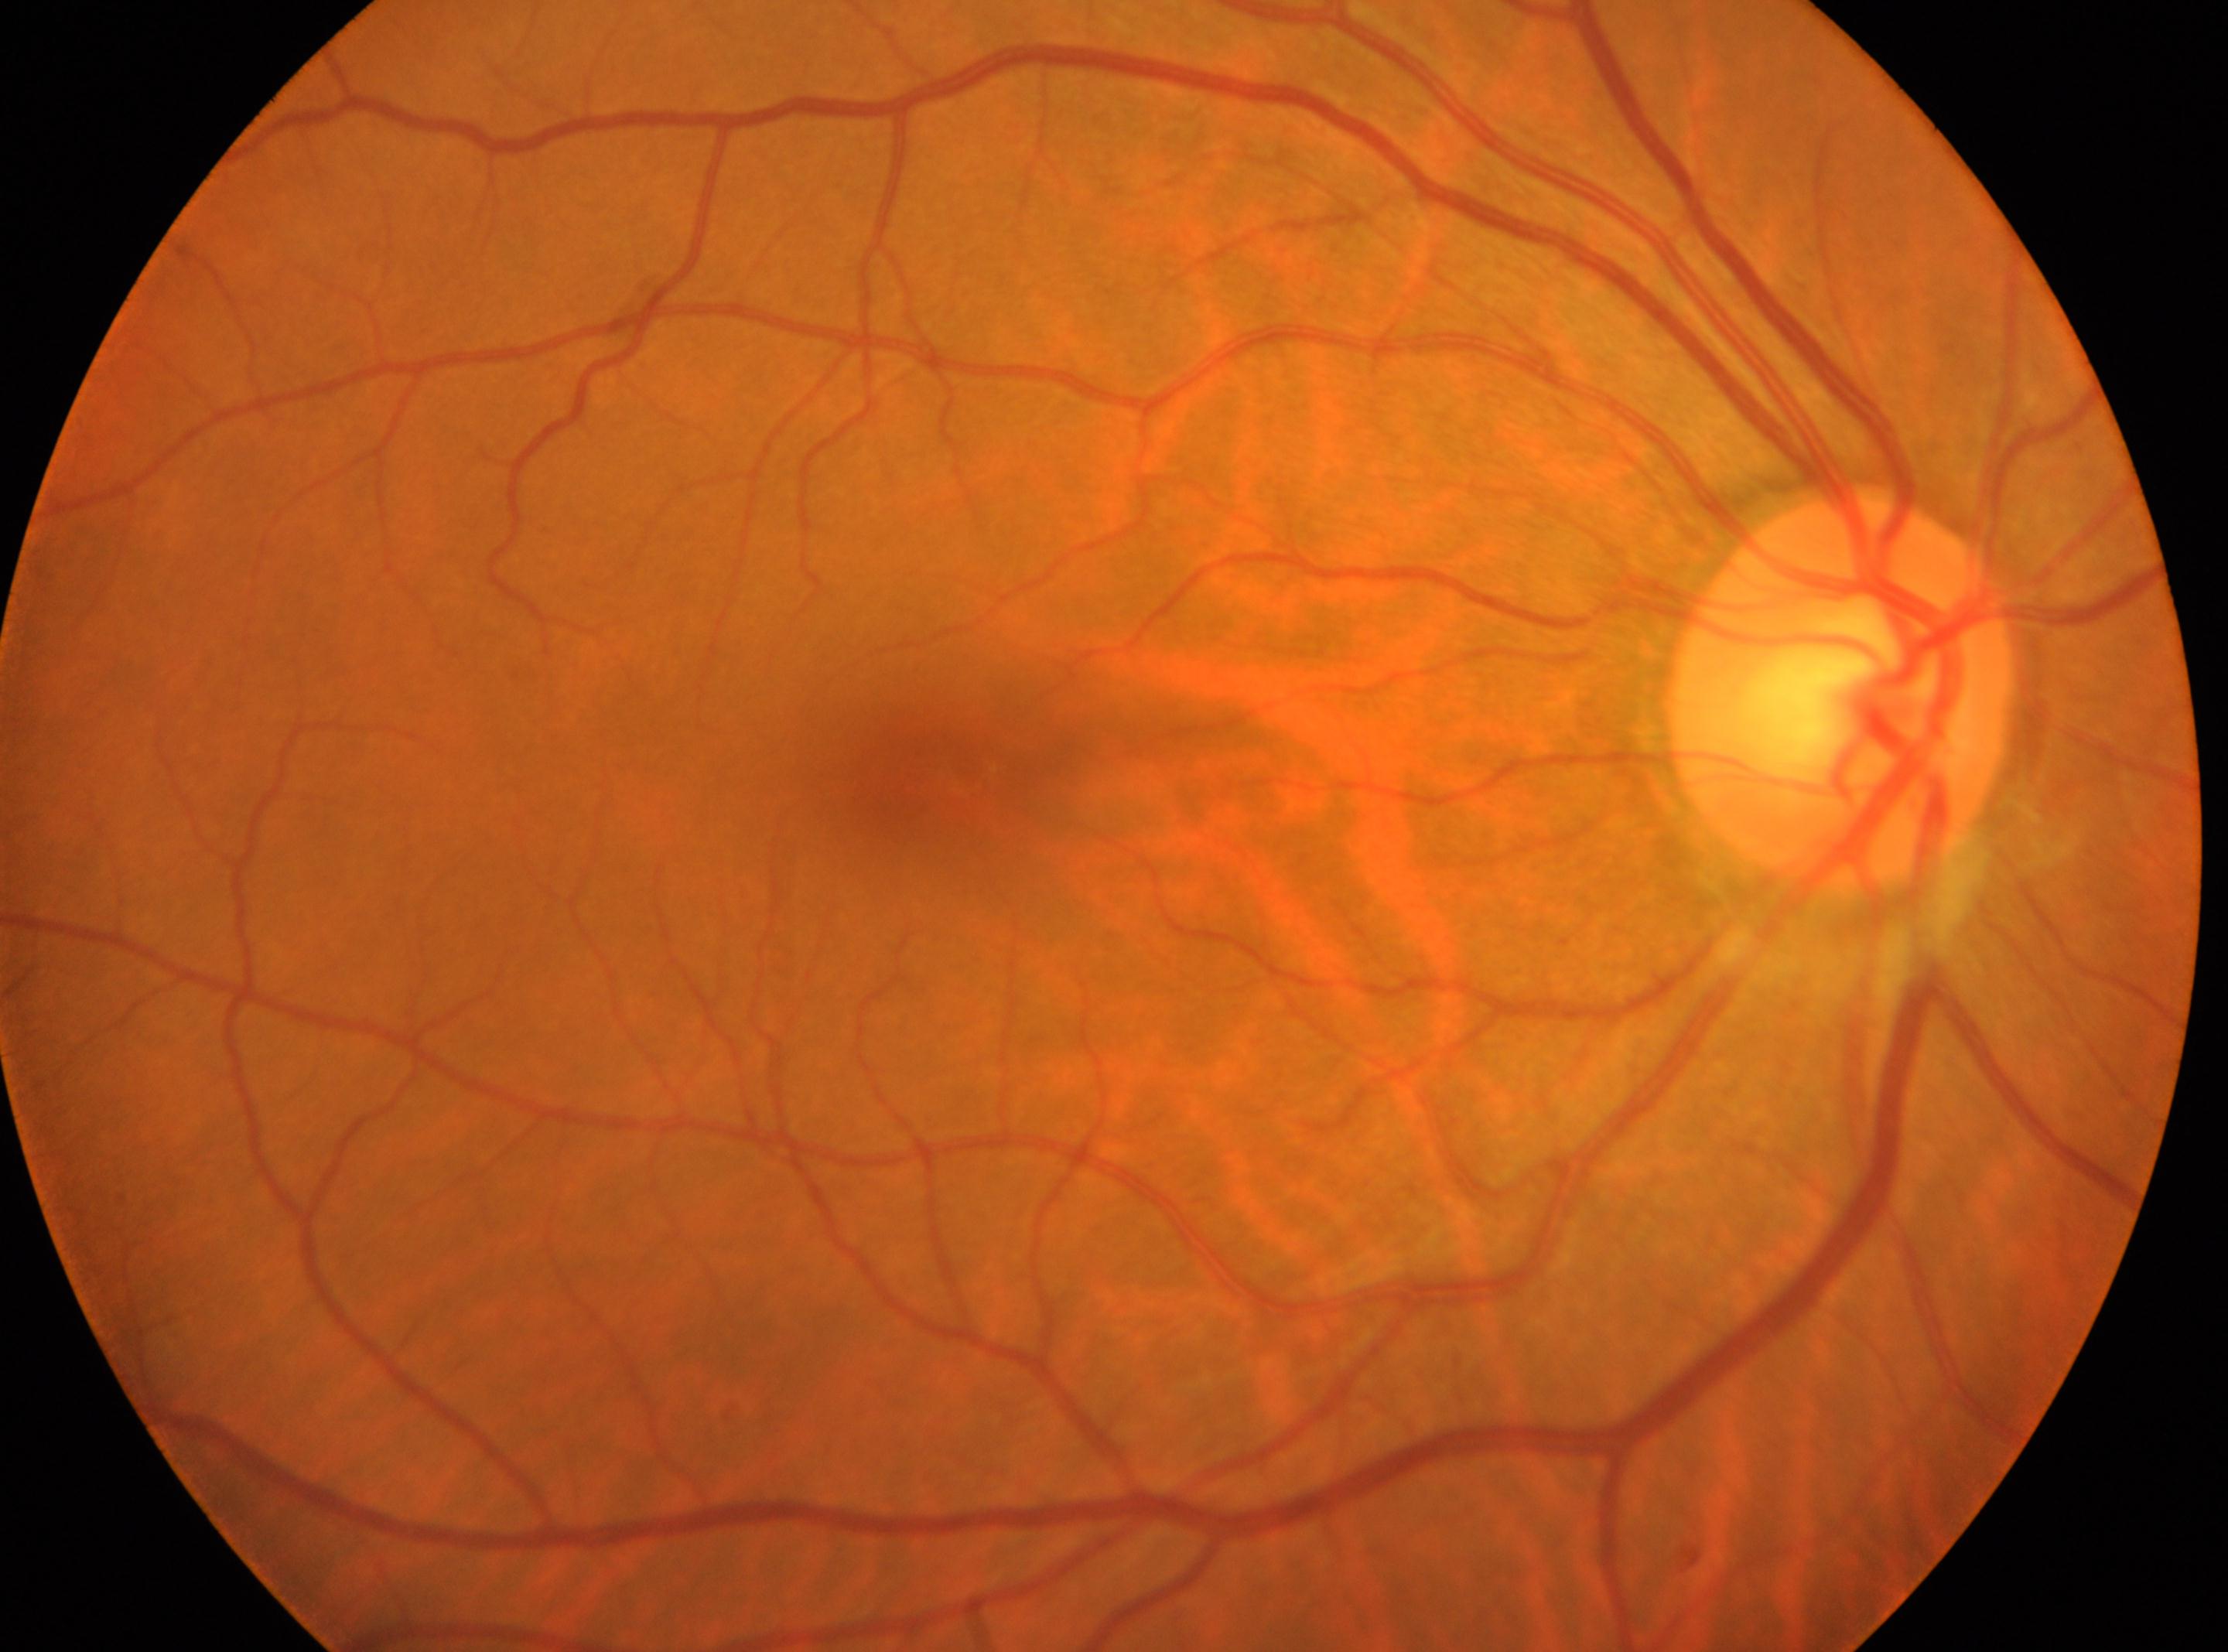
– the fovea · [911, 772]
– diabetic retinopathy (DR) · grade 0 (no apparent retinopathy)
– optic nerve head · [1837, 695]
– eye · OD